Image size 848x848. 45 degree fundus photograph. Graded on the modified Davis scale — 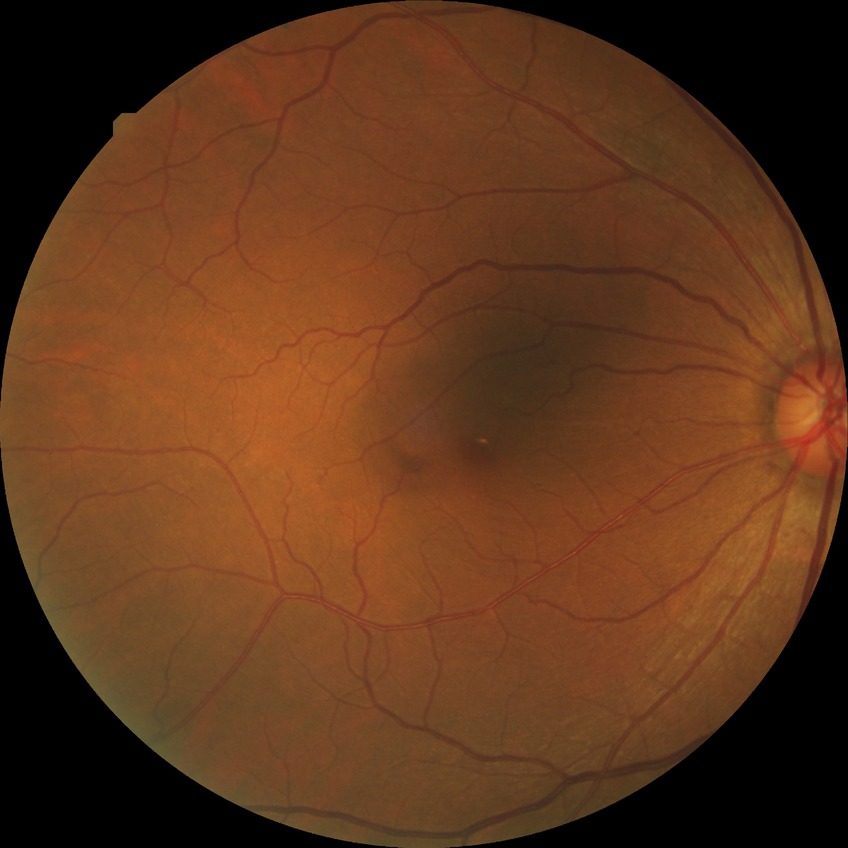
Diabetic retinopathy severity is no diabetic retinopathy.